Graded on the modified Davis scale. CFP. 45° FOV — 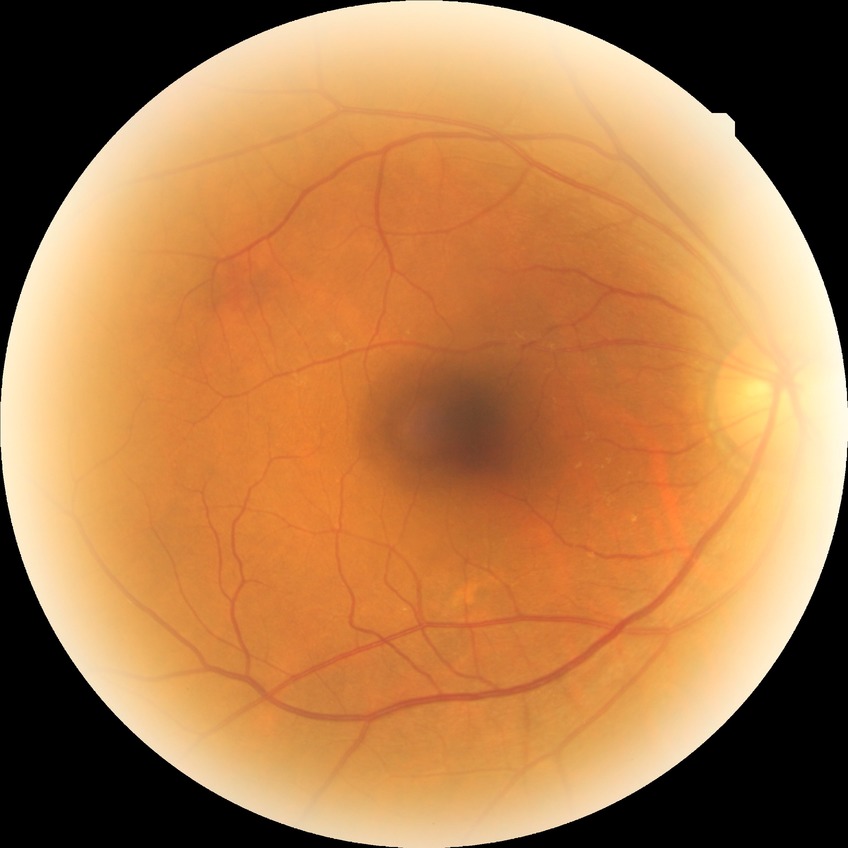

Findings:
• retinopathy grade — no diabetic retinopathy